848x848px · nonmydriatic fundus photograph
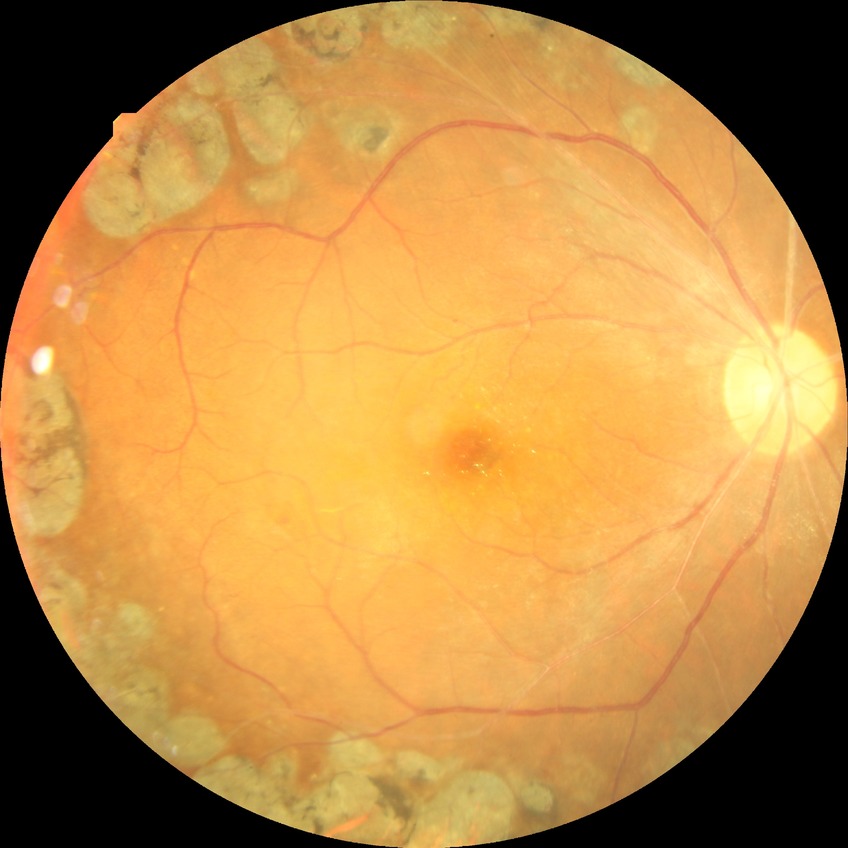 DR severity: PDR.